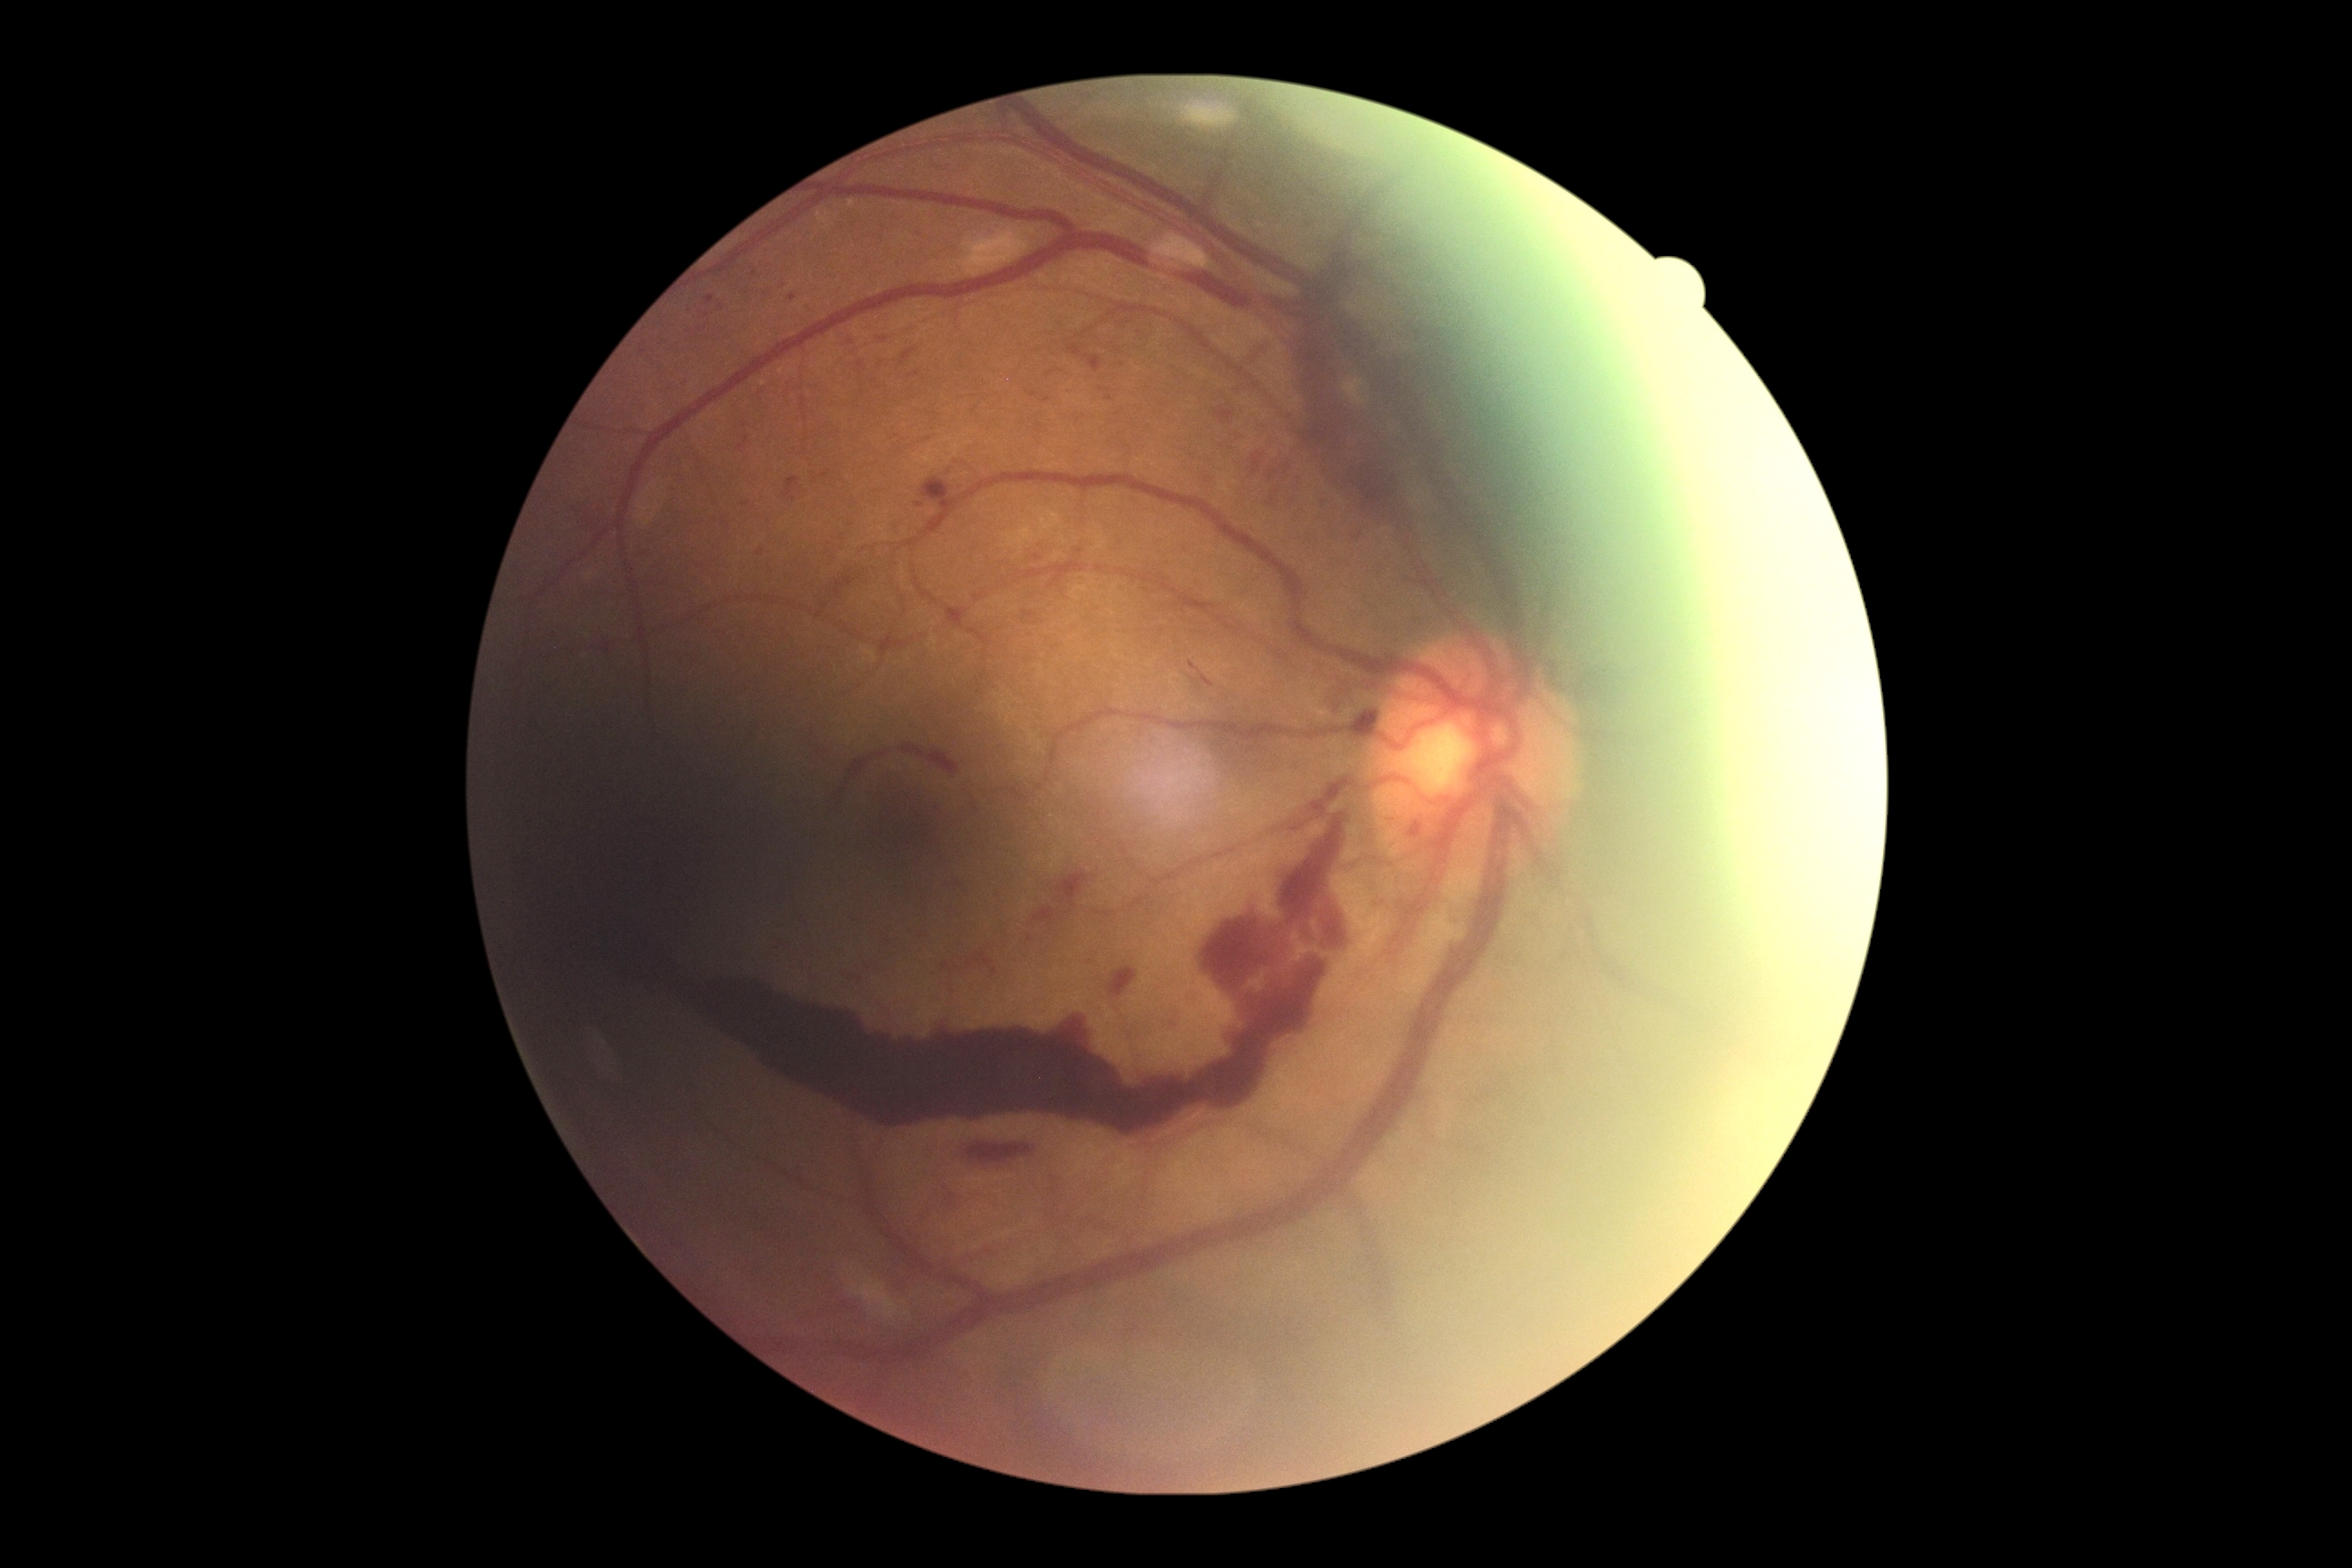 Diabetic retinopathy (DR) is PDR (grade 4).